Graded on the modified Davis scale.
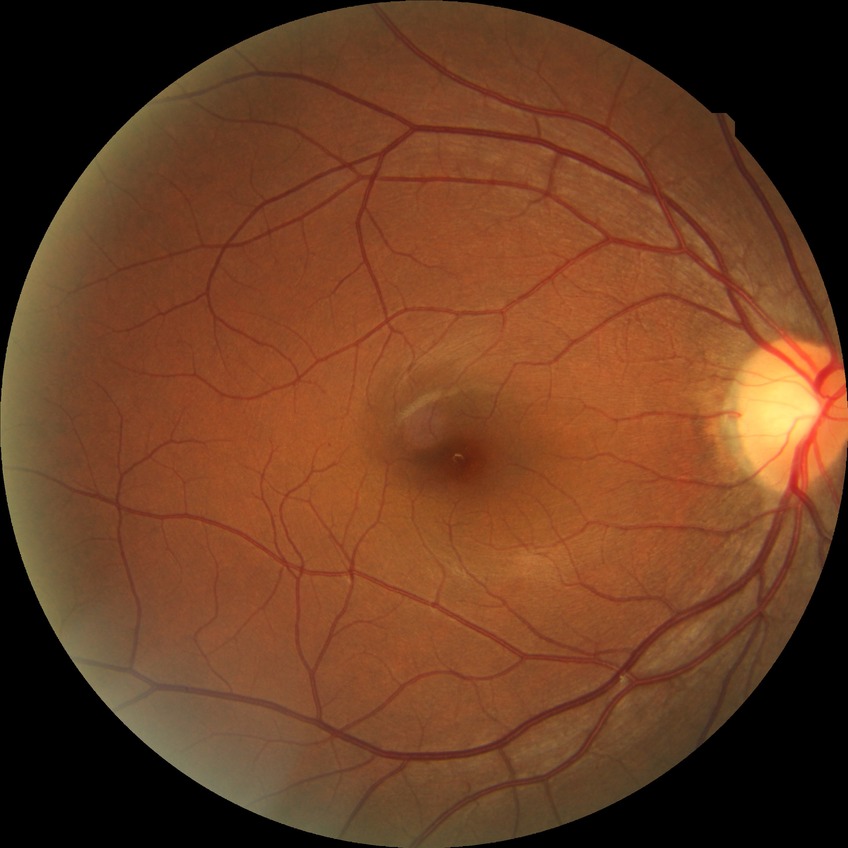 diabetic retinopathy (DR)@NDR (no diabetic retinopathy).